640 x 480 pixels; RetCam wide-field infant fundus image; Clarity RetCam 3, 130° FOV.
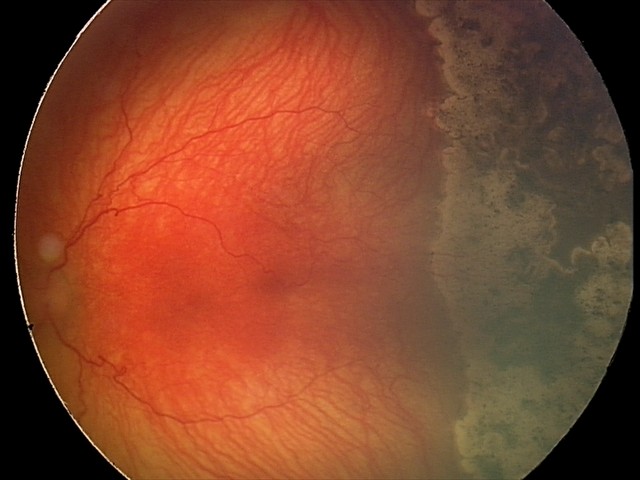 Assessment: plus disease | A-ROP (aggressive ROP).